Natus RetCam Envision, 130° FOV; wide-field fundus image from infant ROP screening — 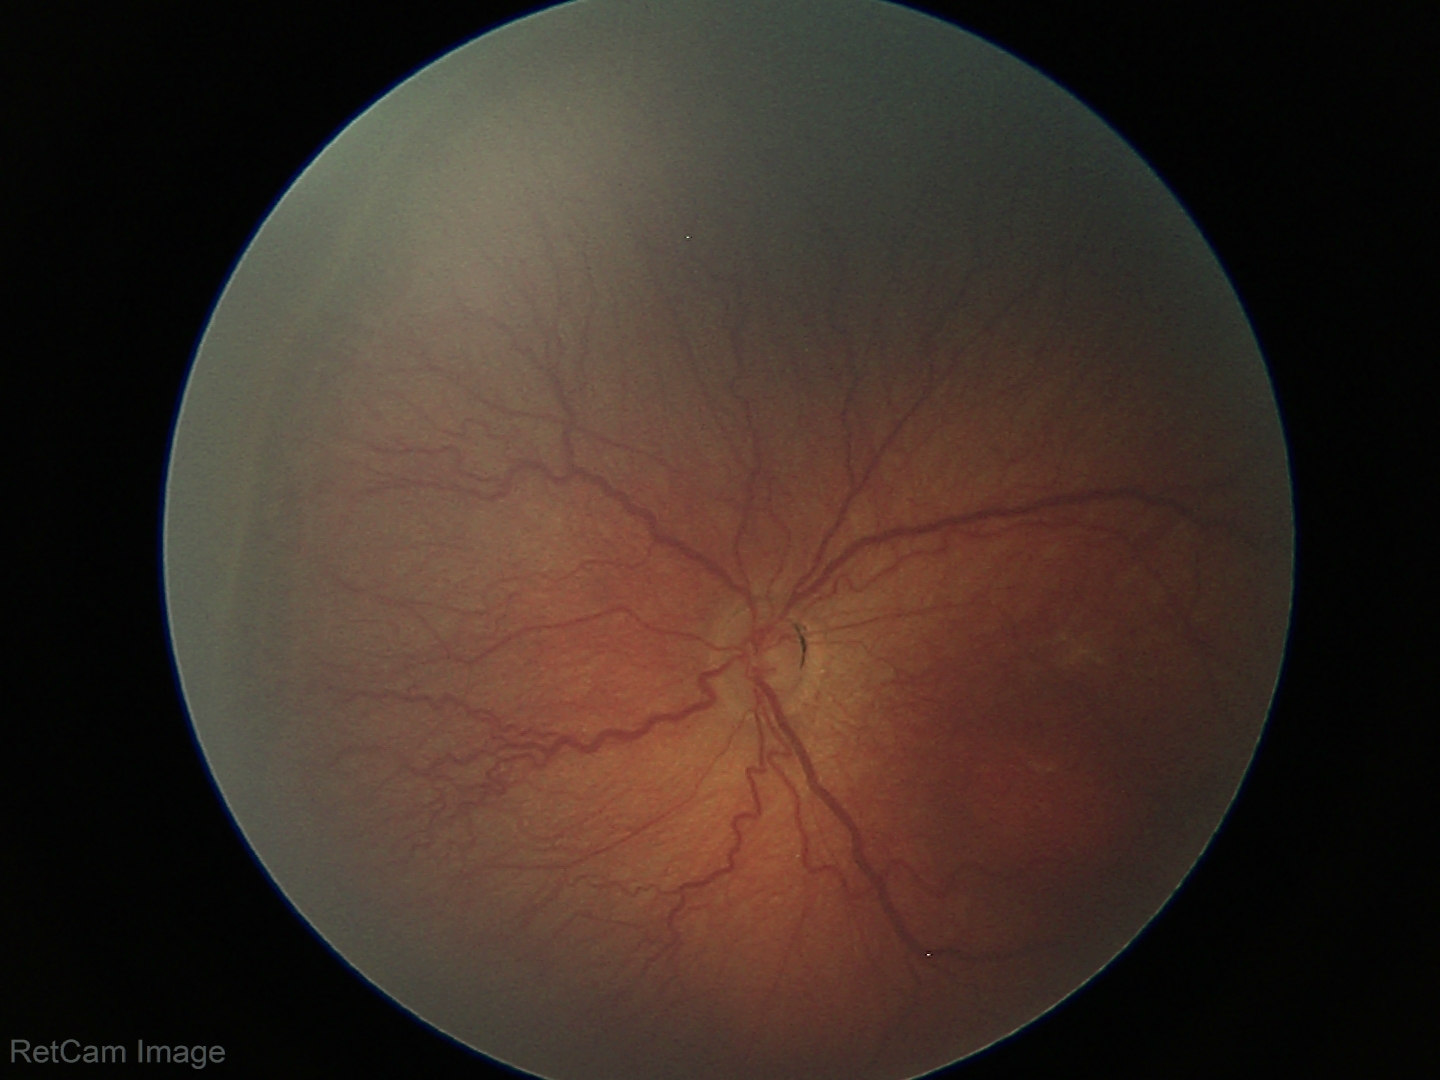 Screening examination consistent with ROP stage 3.